45° field of view · 2144x1424px.
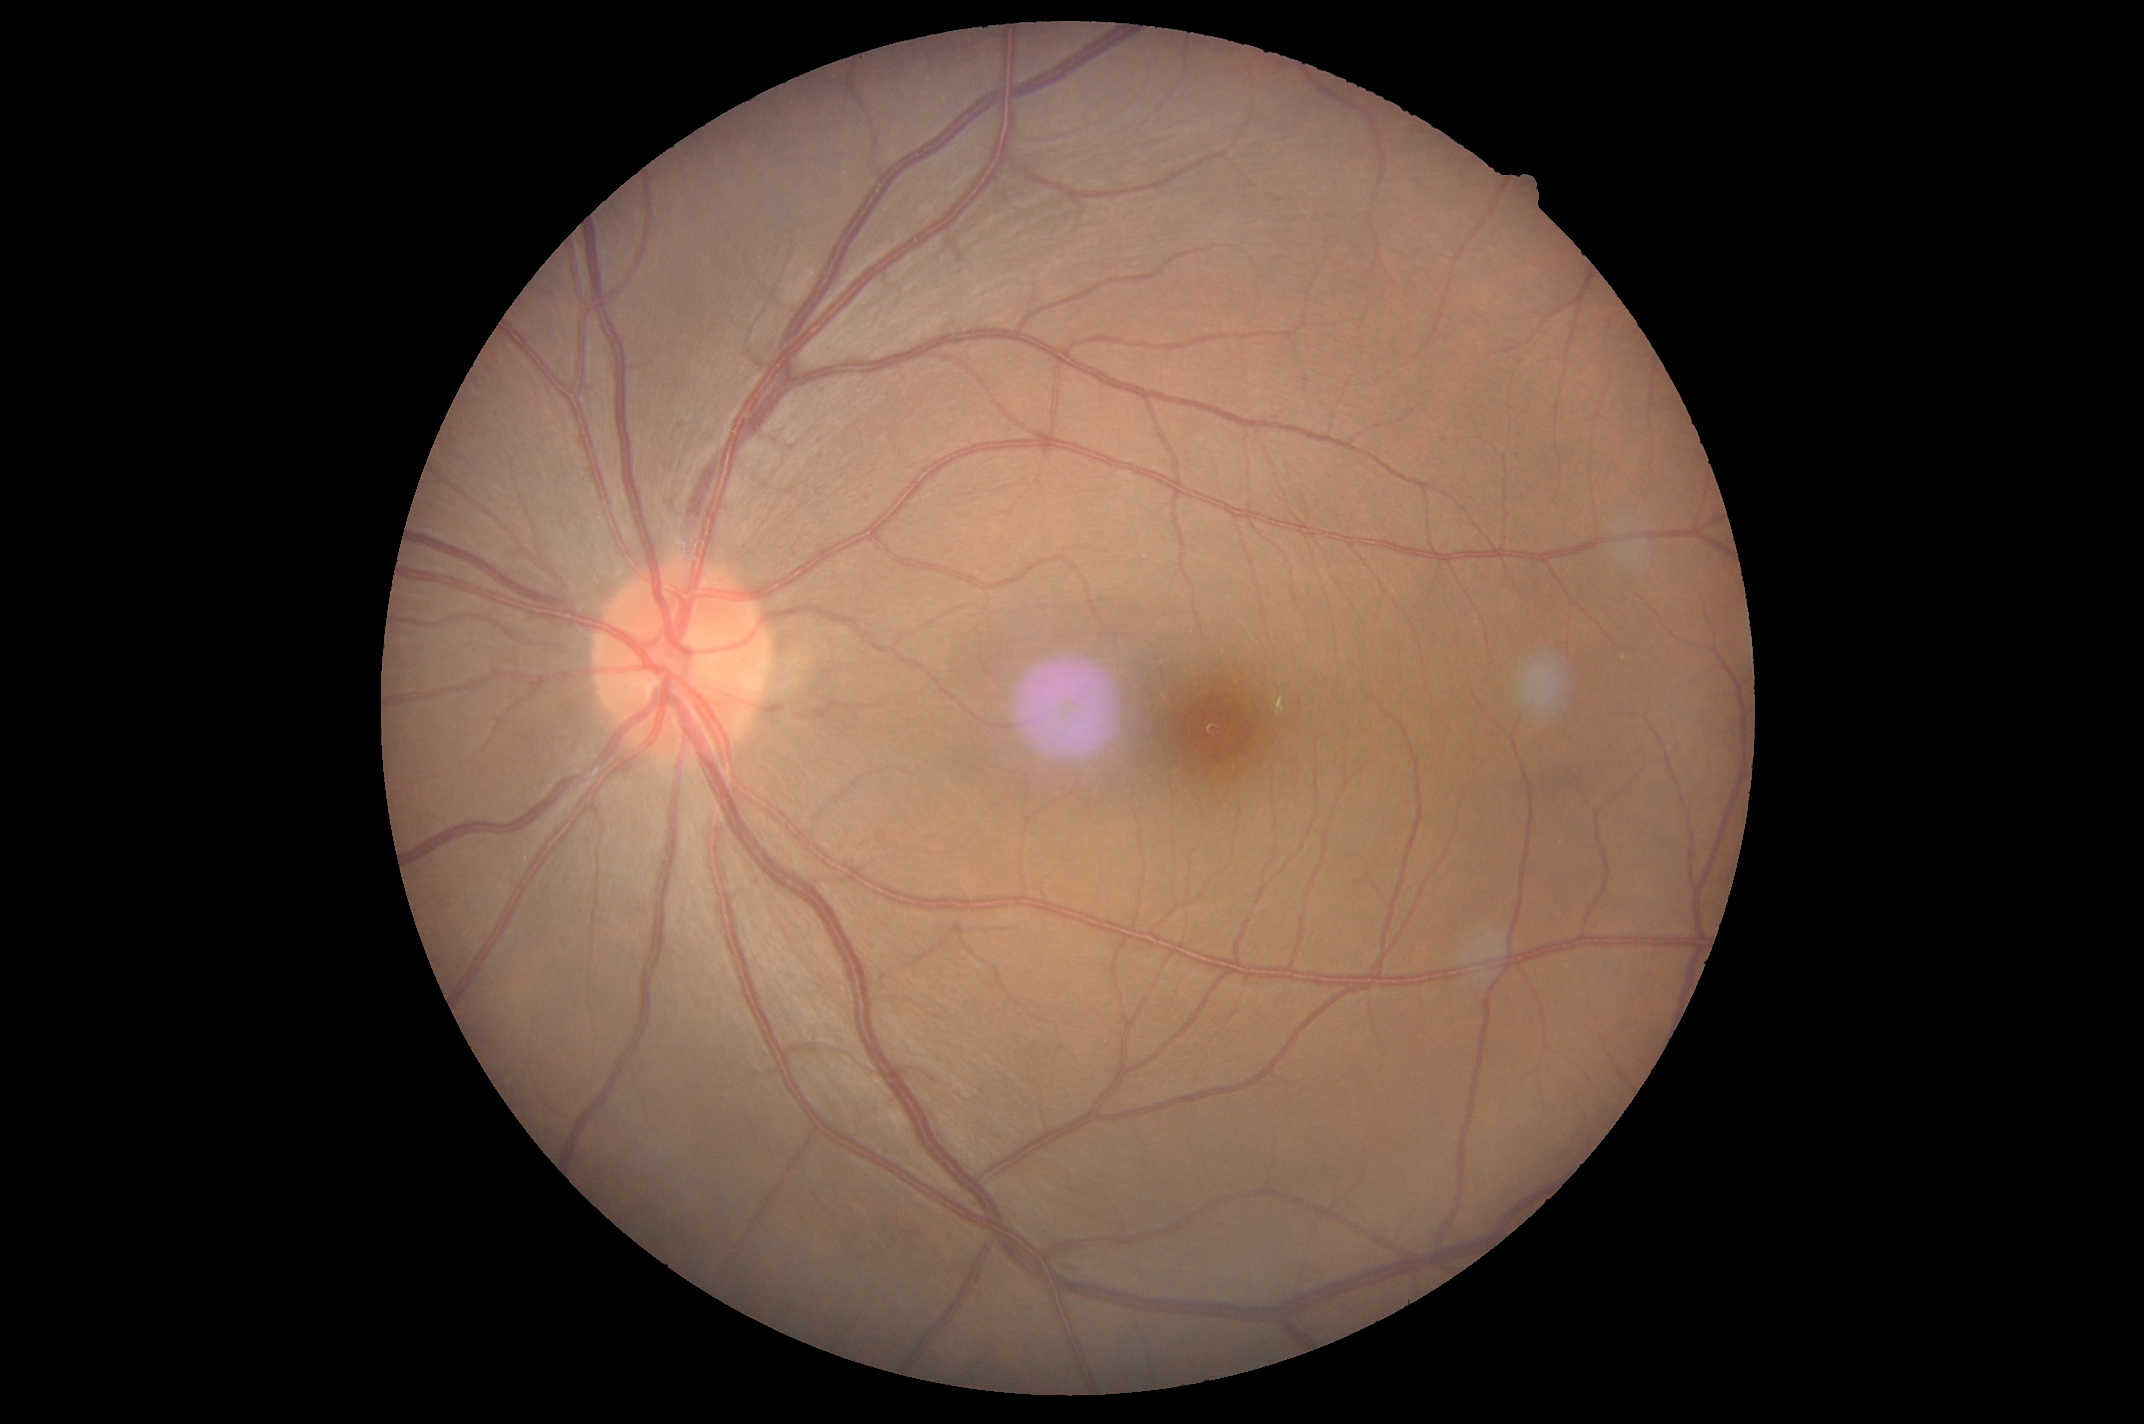

DR severity = 2
DR class = non-proliferative diabetic retinopathy